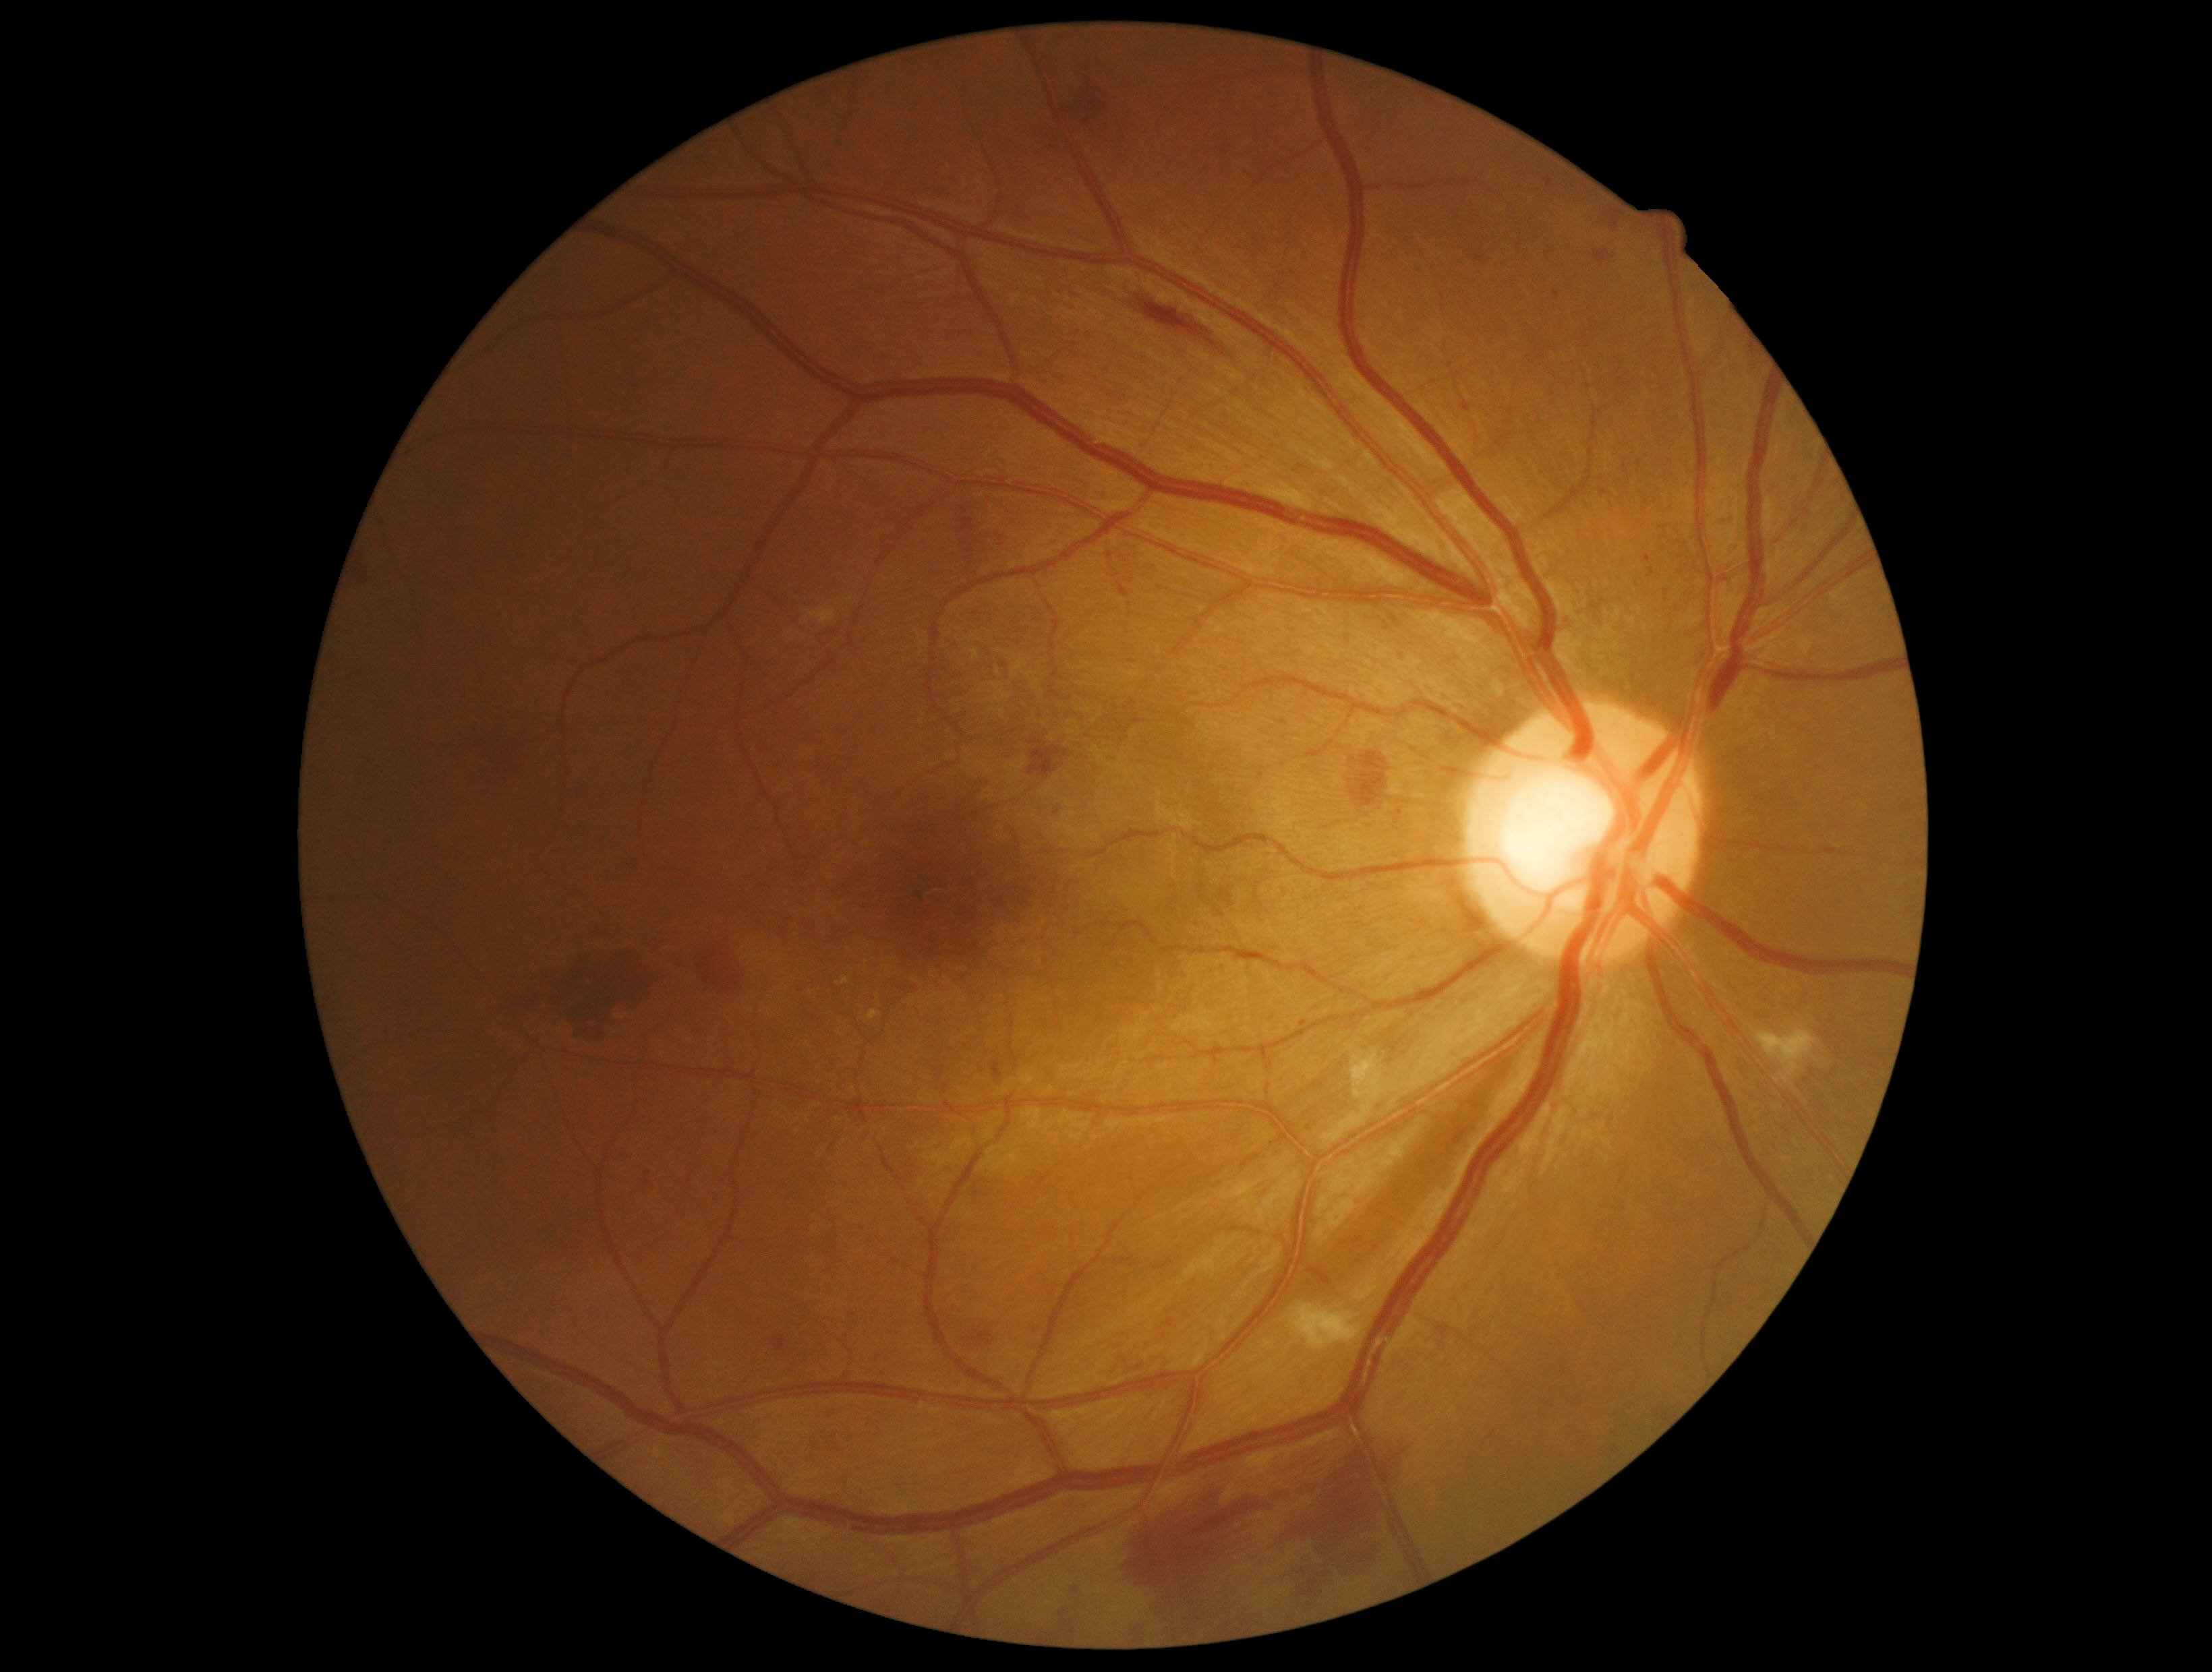

dr_grade: grade 2 (moderate NPDR)
dr_category: non-proliferative diabetic retinopathy